Image size 640x480. Wide-field fundus photograph from neonatal ROP screening
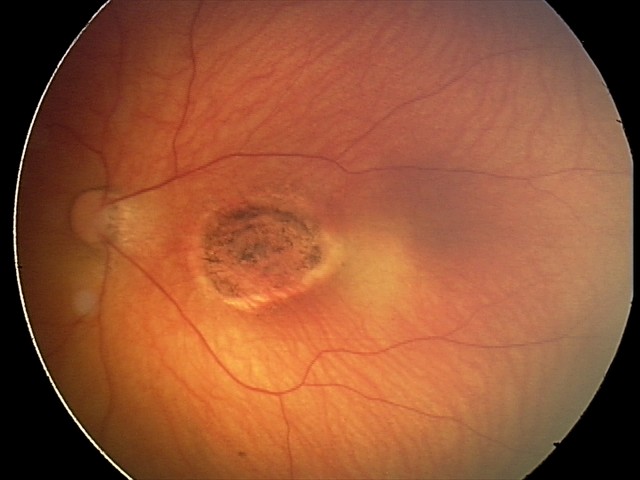
Diagnosis: toxoplasmosis chorioretinitis.